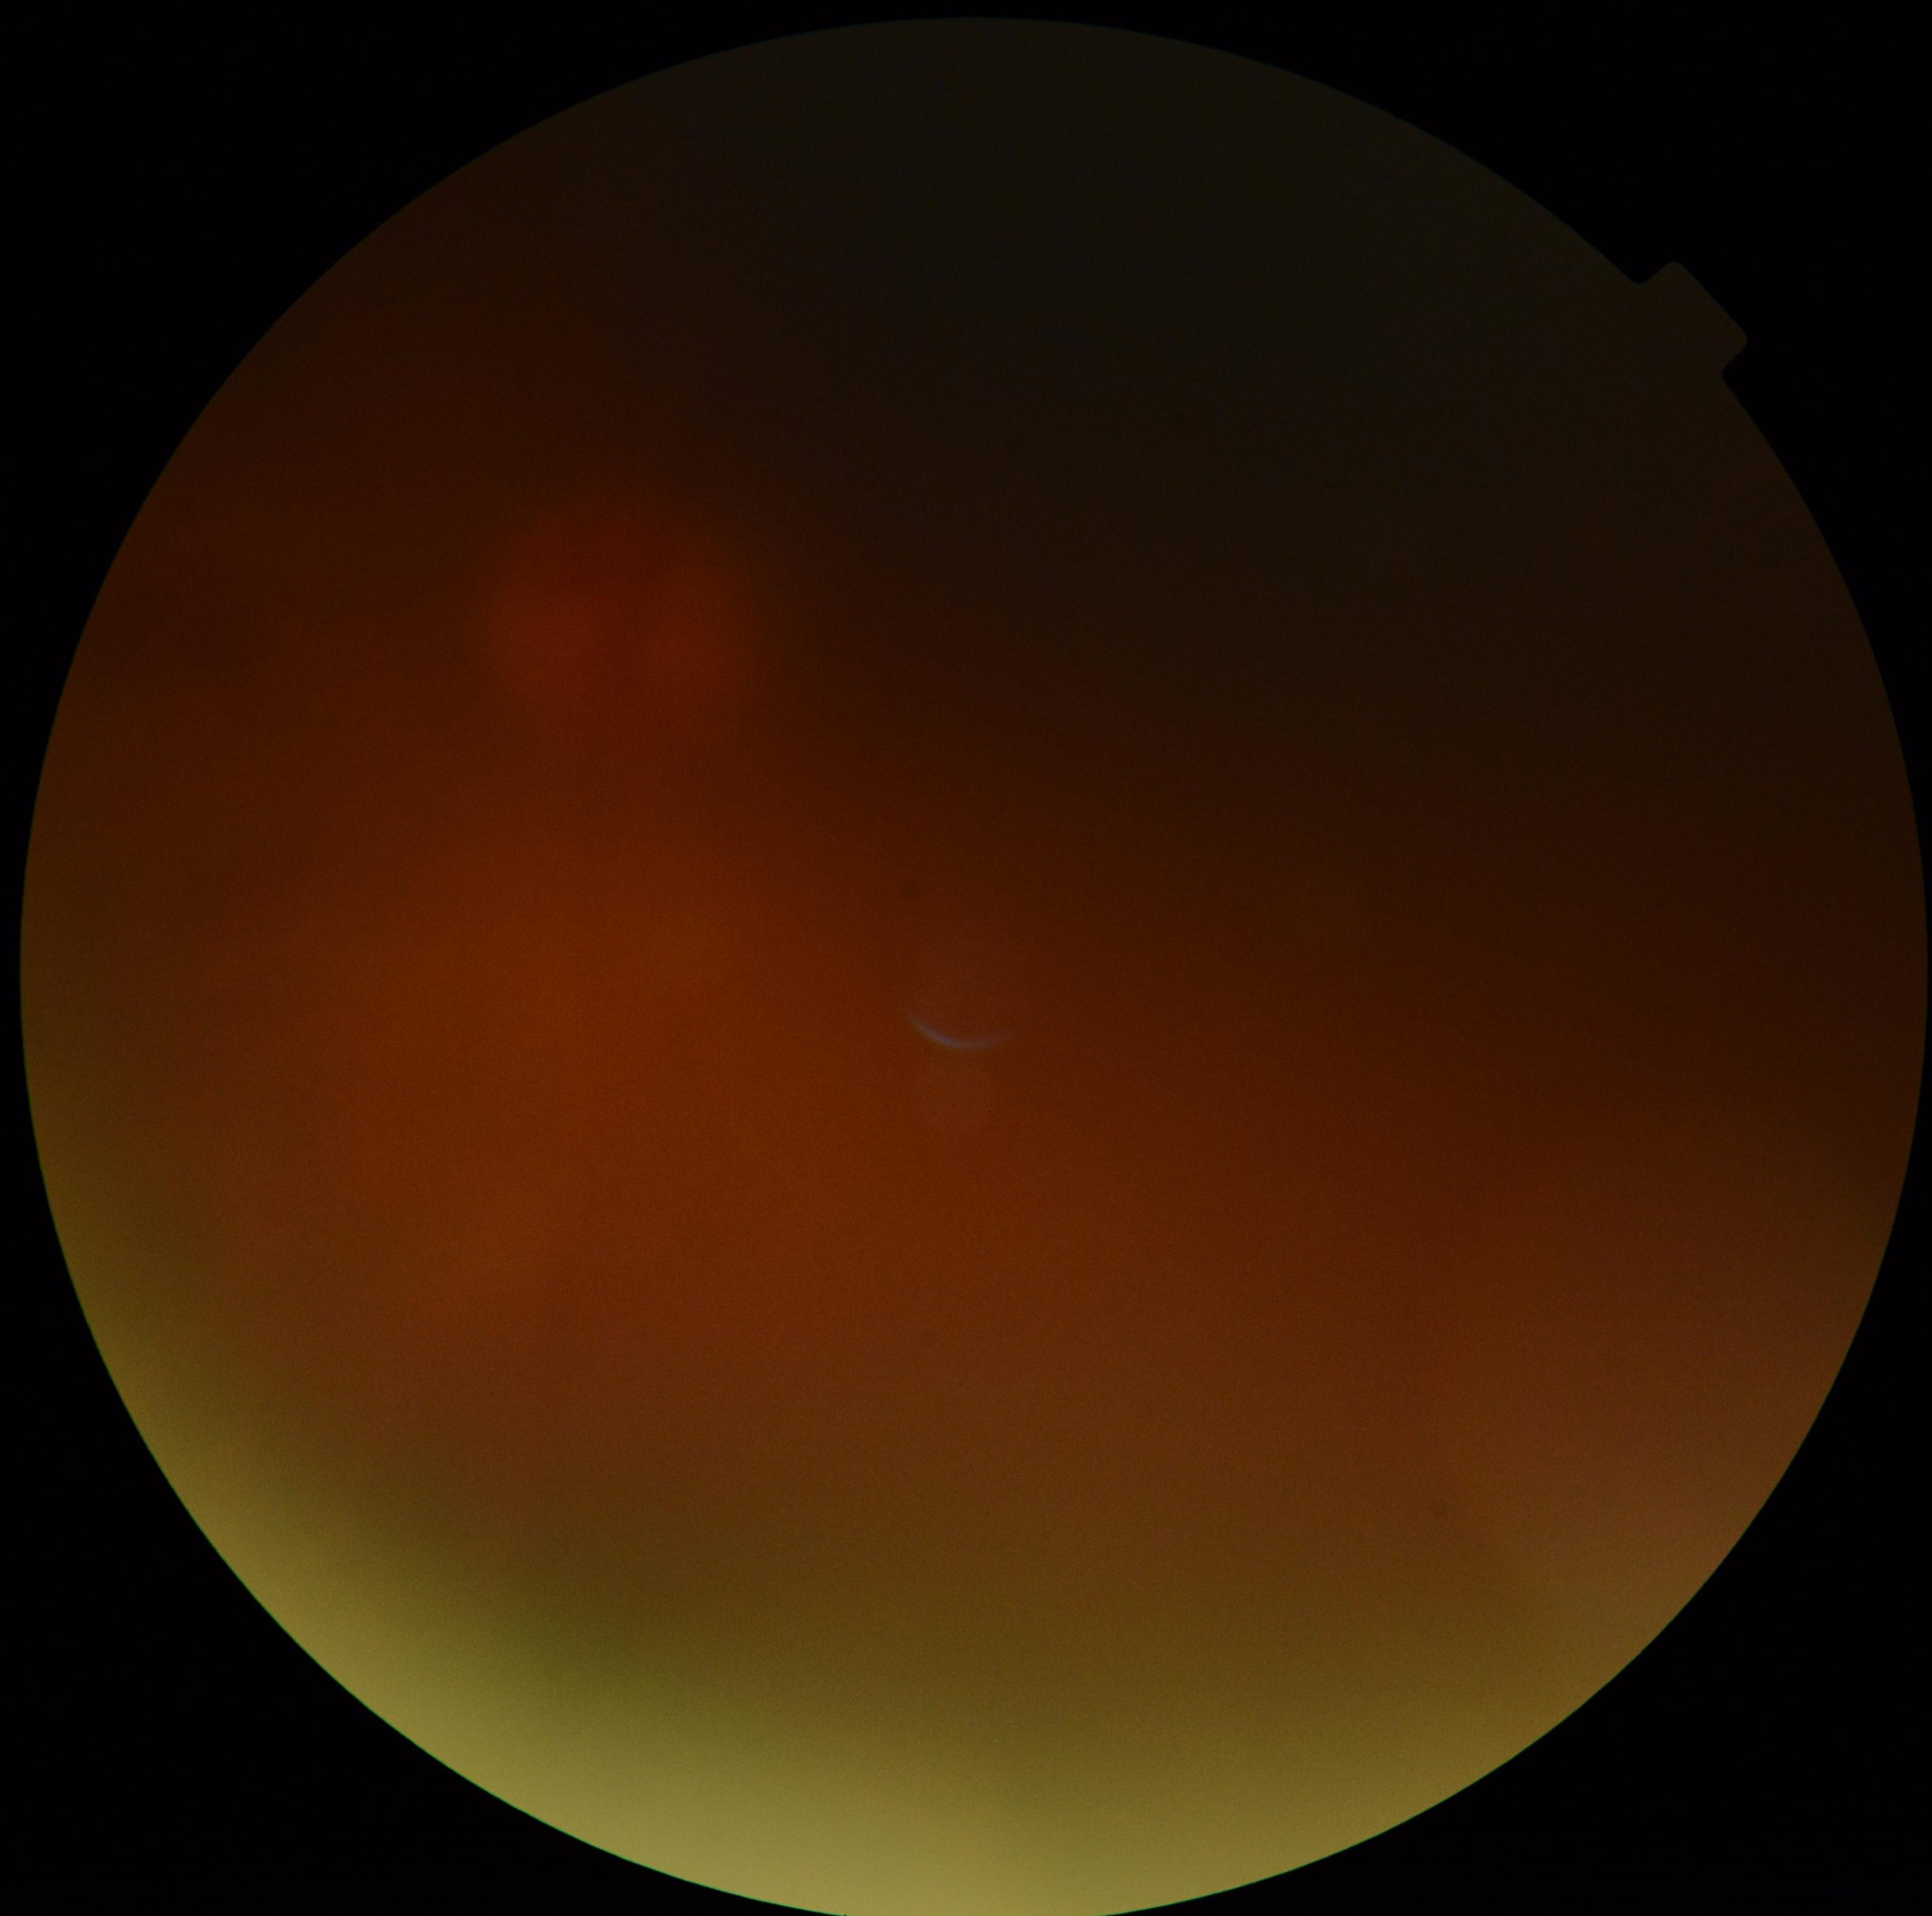 Retinopathy grade: ungradable due to poor image quality. Image quality is insufficient for diabetic retinopathy assessment.